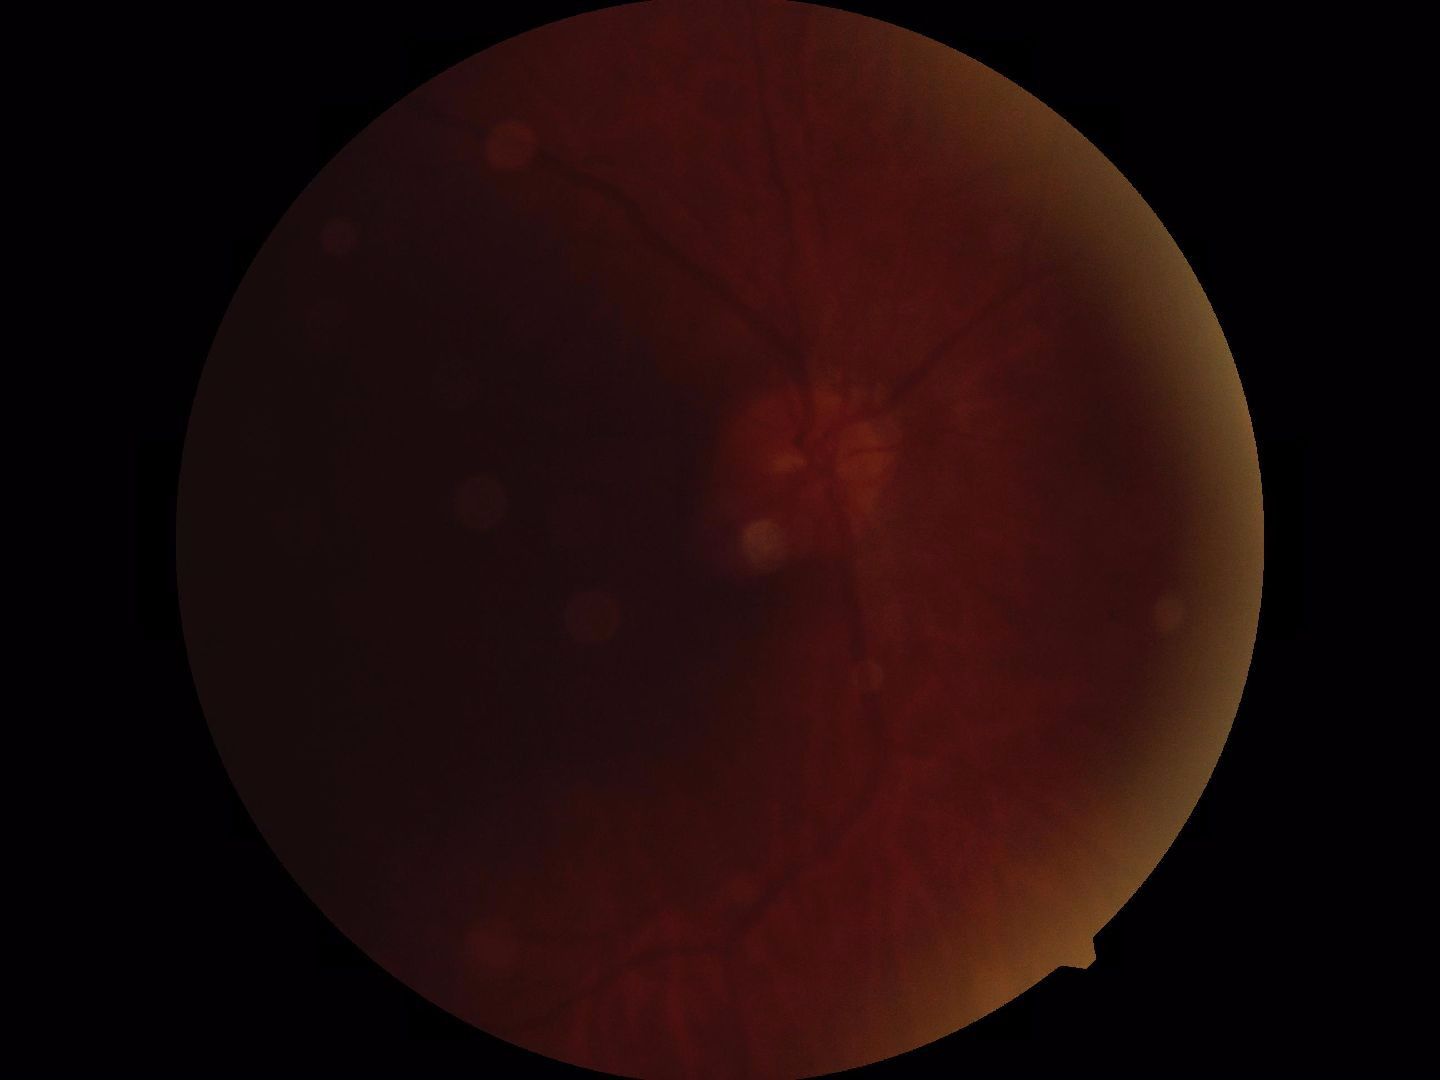 Quality: blurred, more than half the field obscured. Proliferative retinopathy: no evidence.